2361x1568px, macula-centered, retinal fundus photograph, 50° field of view, captured after pupil dilation.
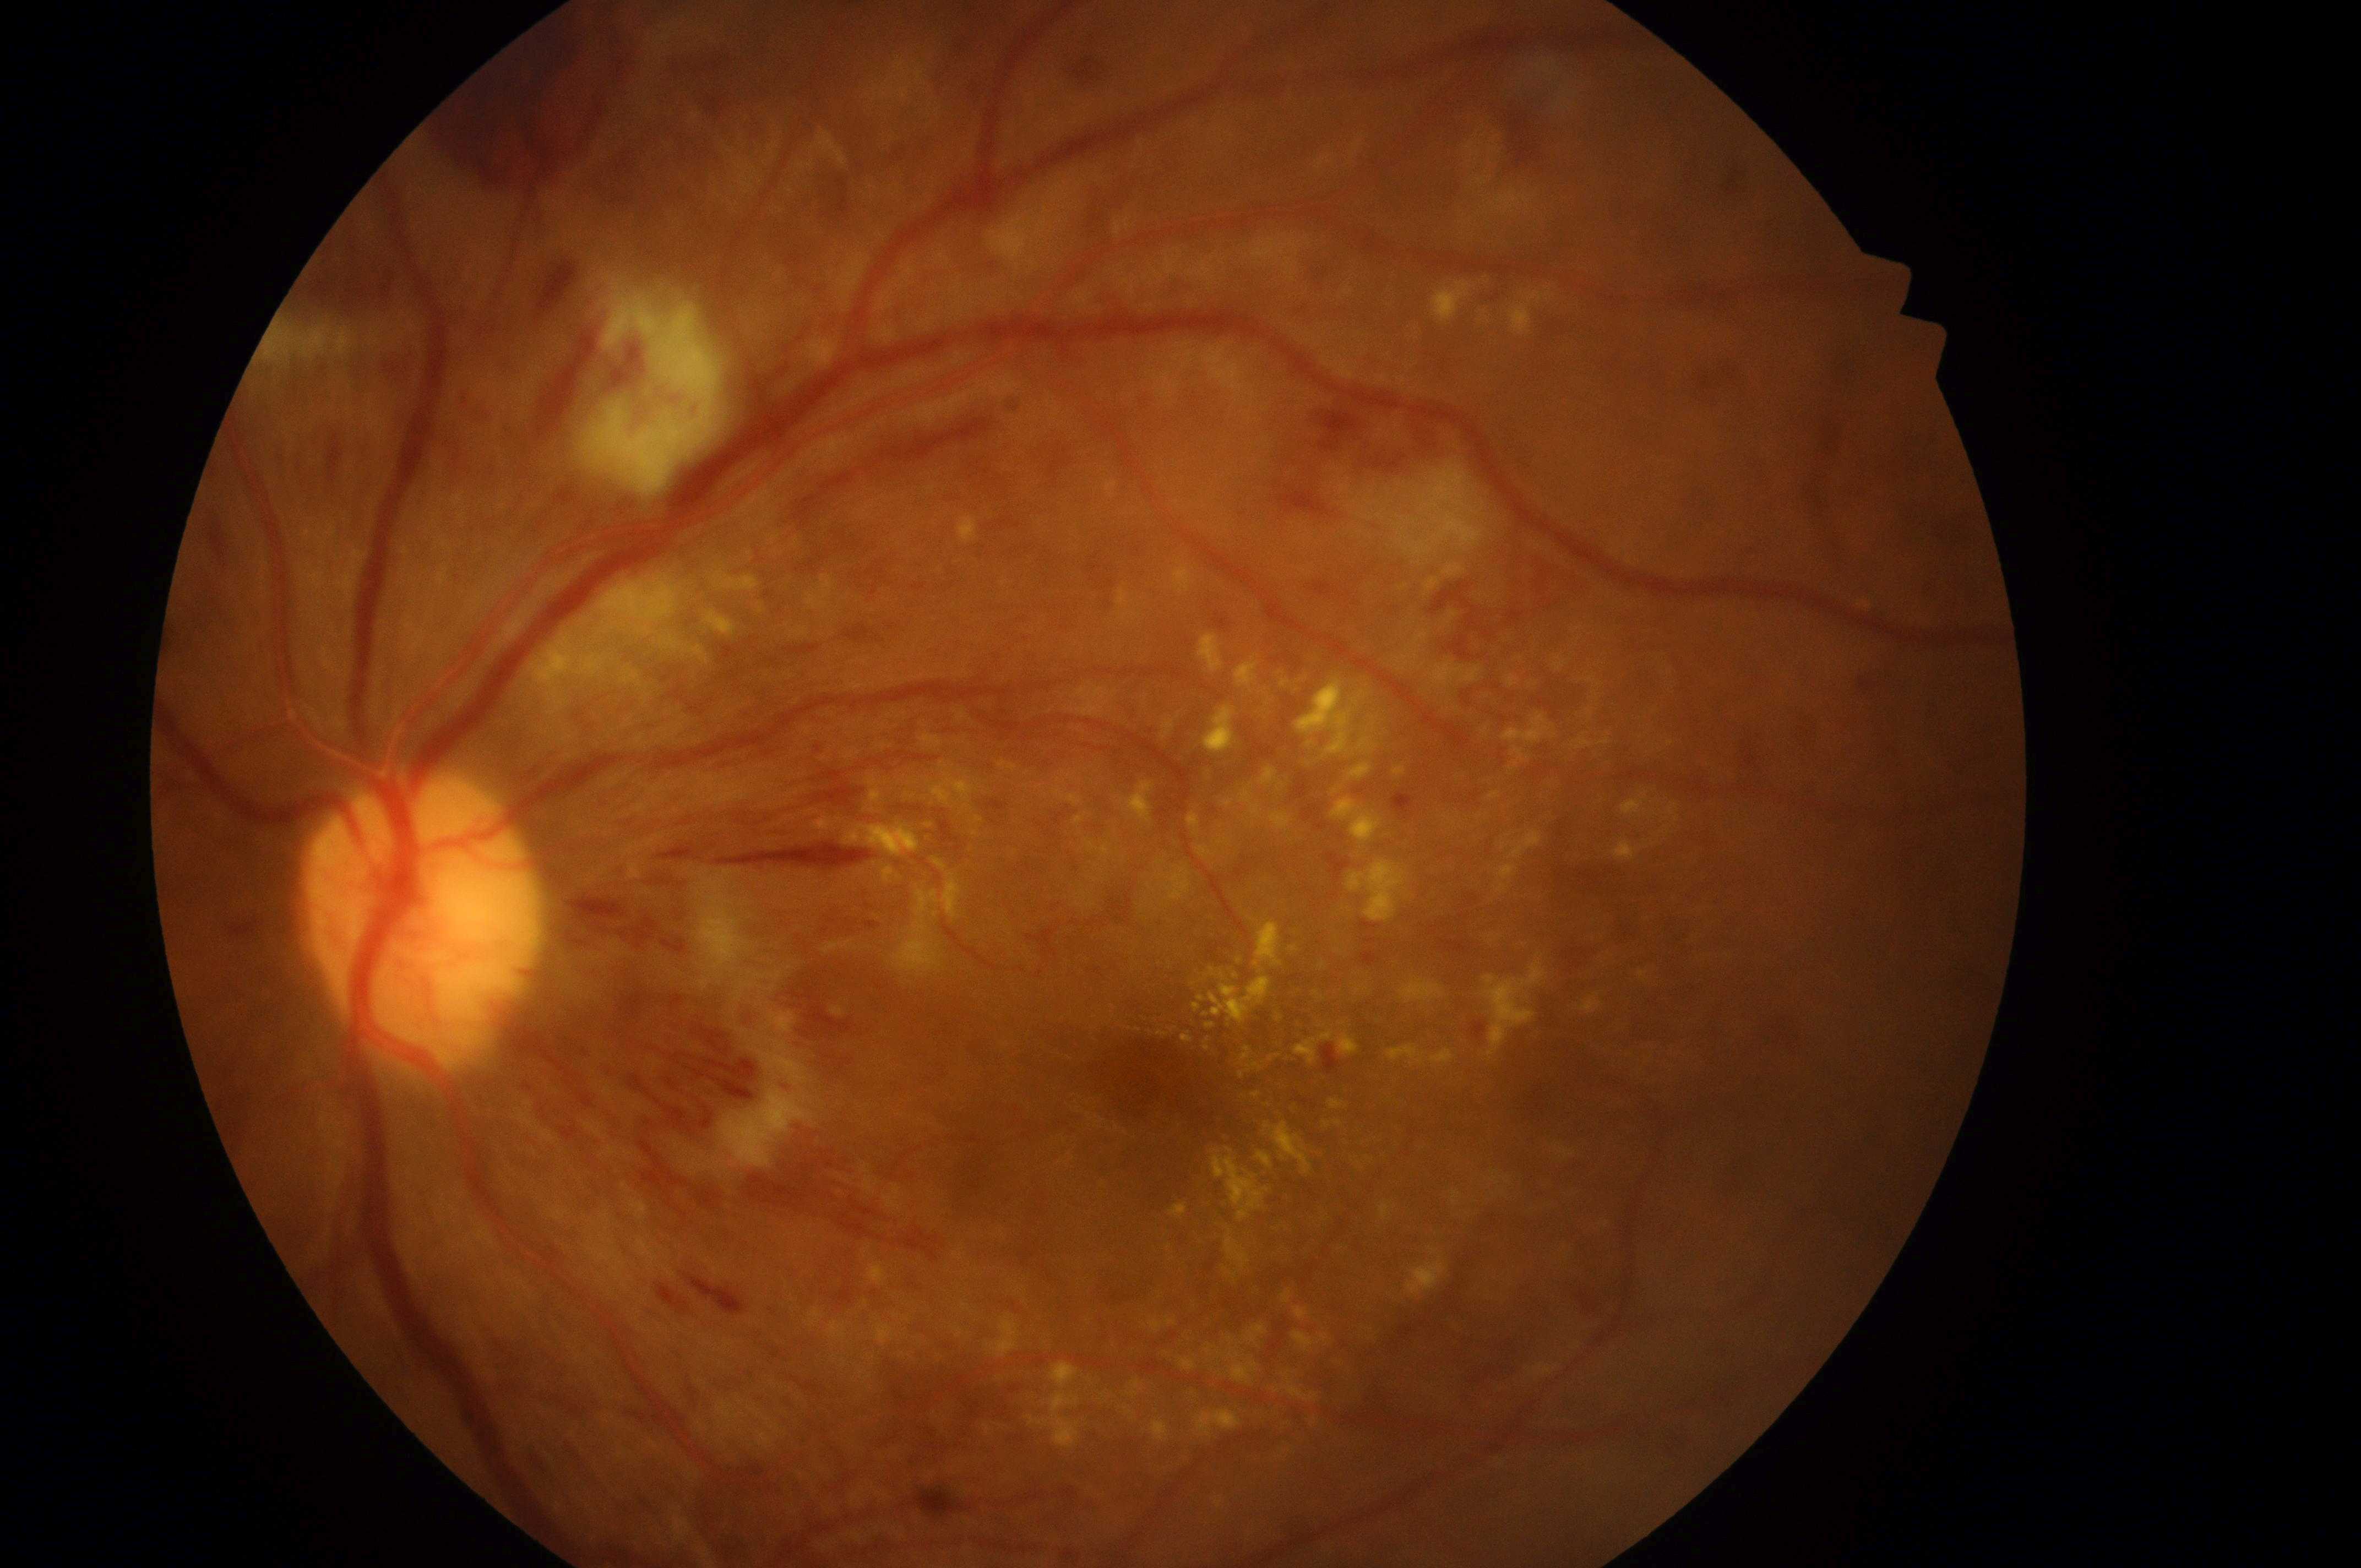 The optic nerve head is at (x=416, y=925).
DME risk is 2.
DR severity: 4/4.
The image shows the OS.
Macular center: (x=1155, y=1088).